Infant wide-field retinal image
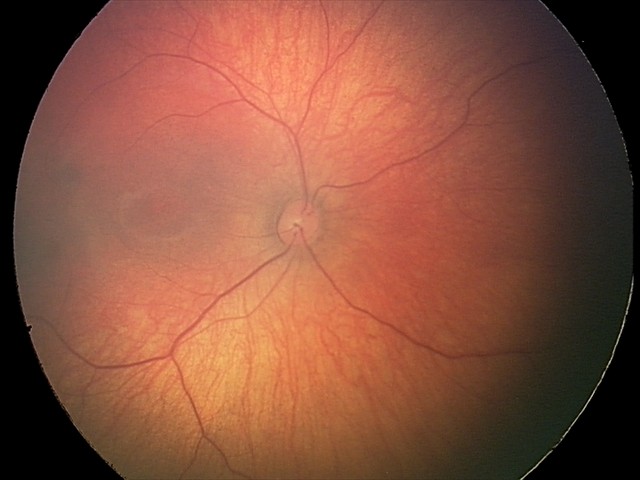 Impression: retinal hemorrhages.